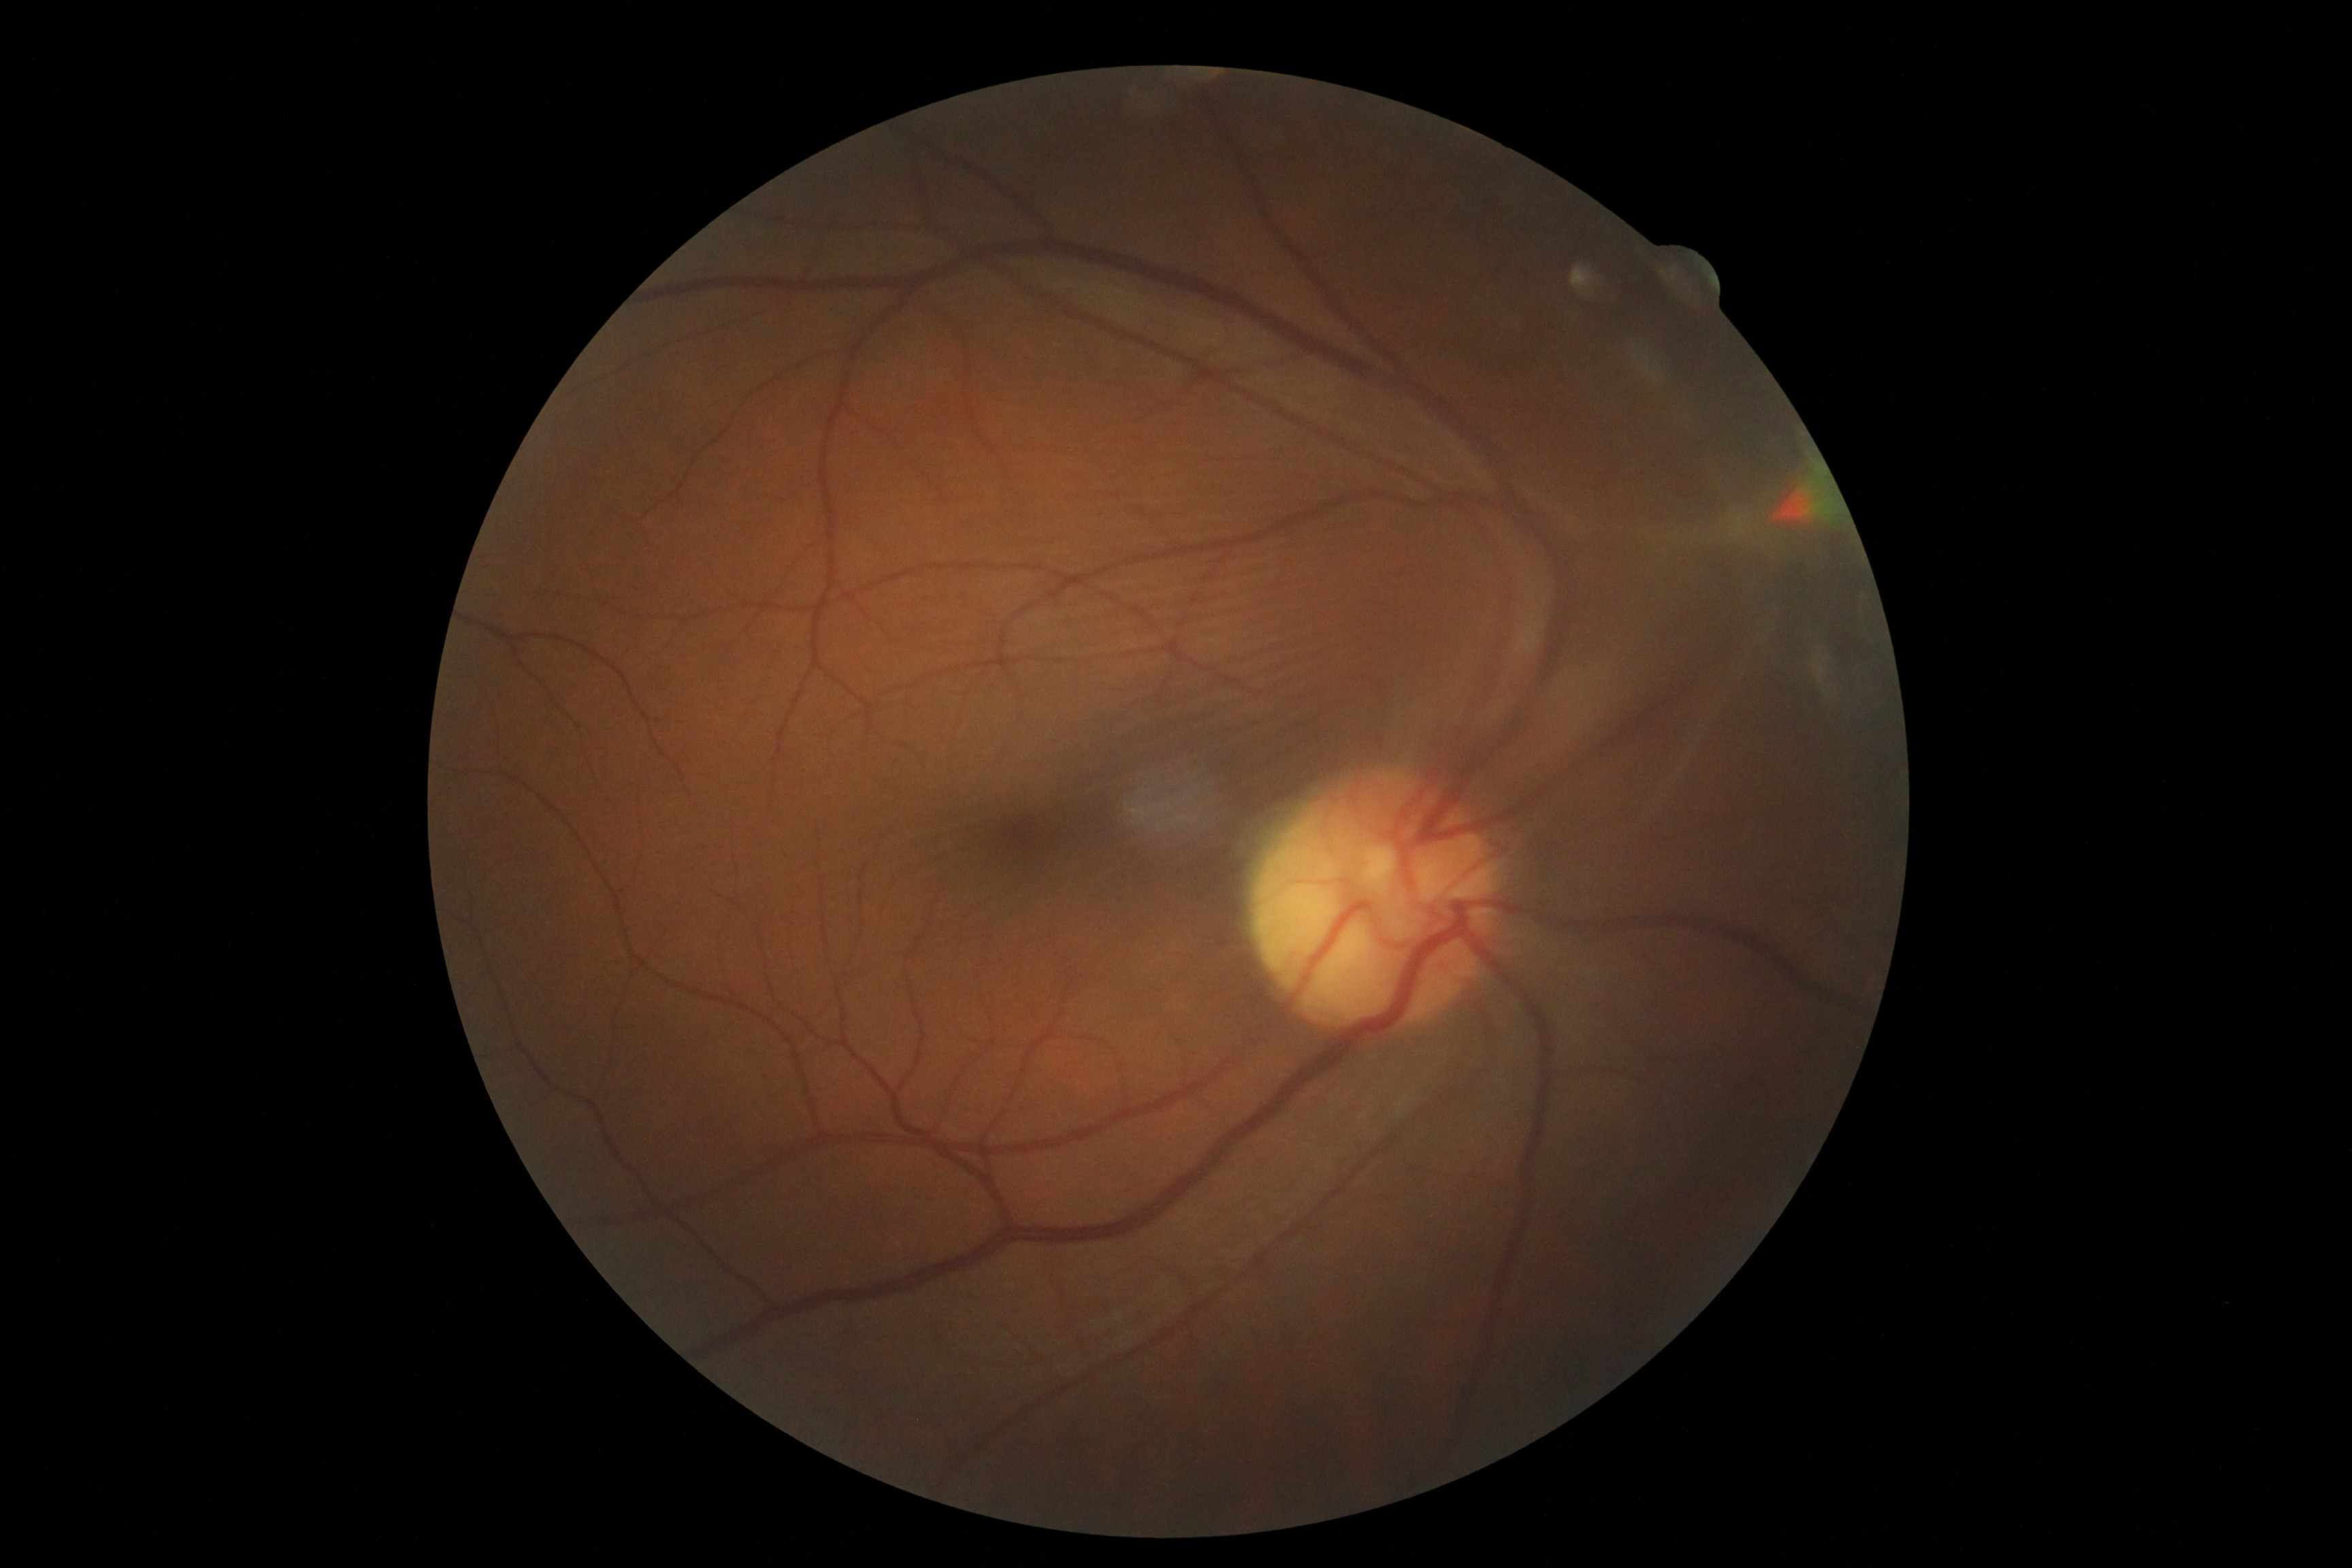 DR grade: 4 (PDR) — neovascularization and/or vitreous/pre-retinal hemorrhage | DR class: proliferative diabetic retinopathy.